240 by 240 pixels:
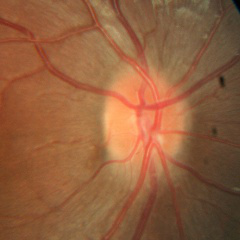 Assessment = no glaucomatous findings.